Graded on the modified Davis scale
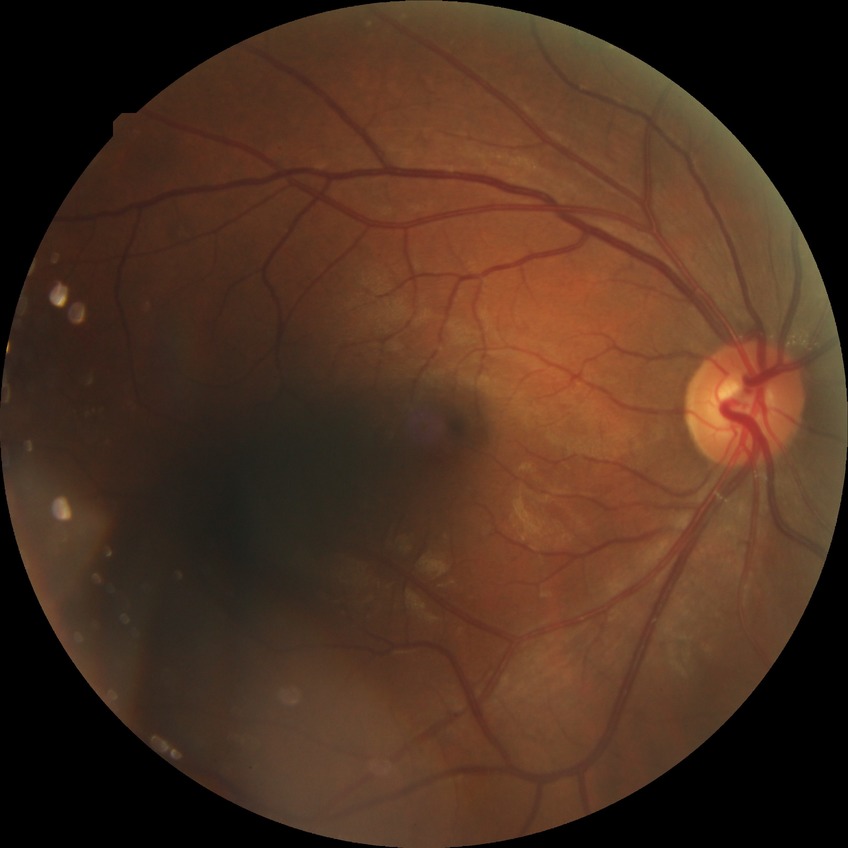 Davis DR grade: SDR.